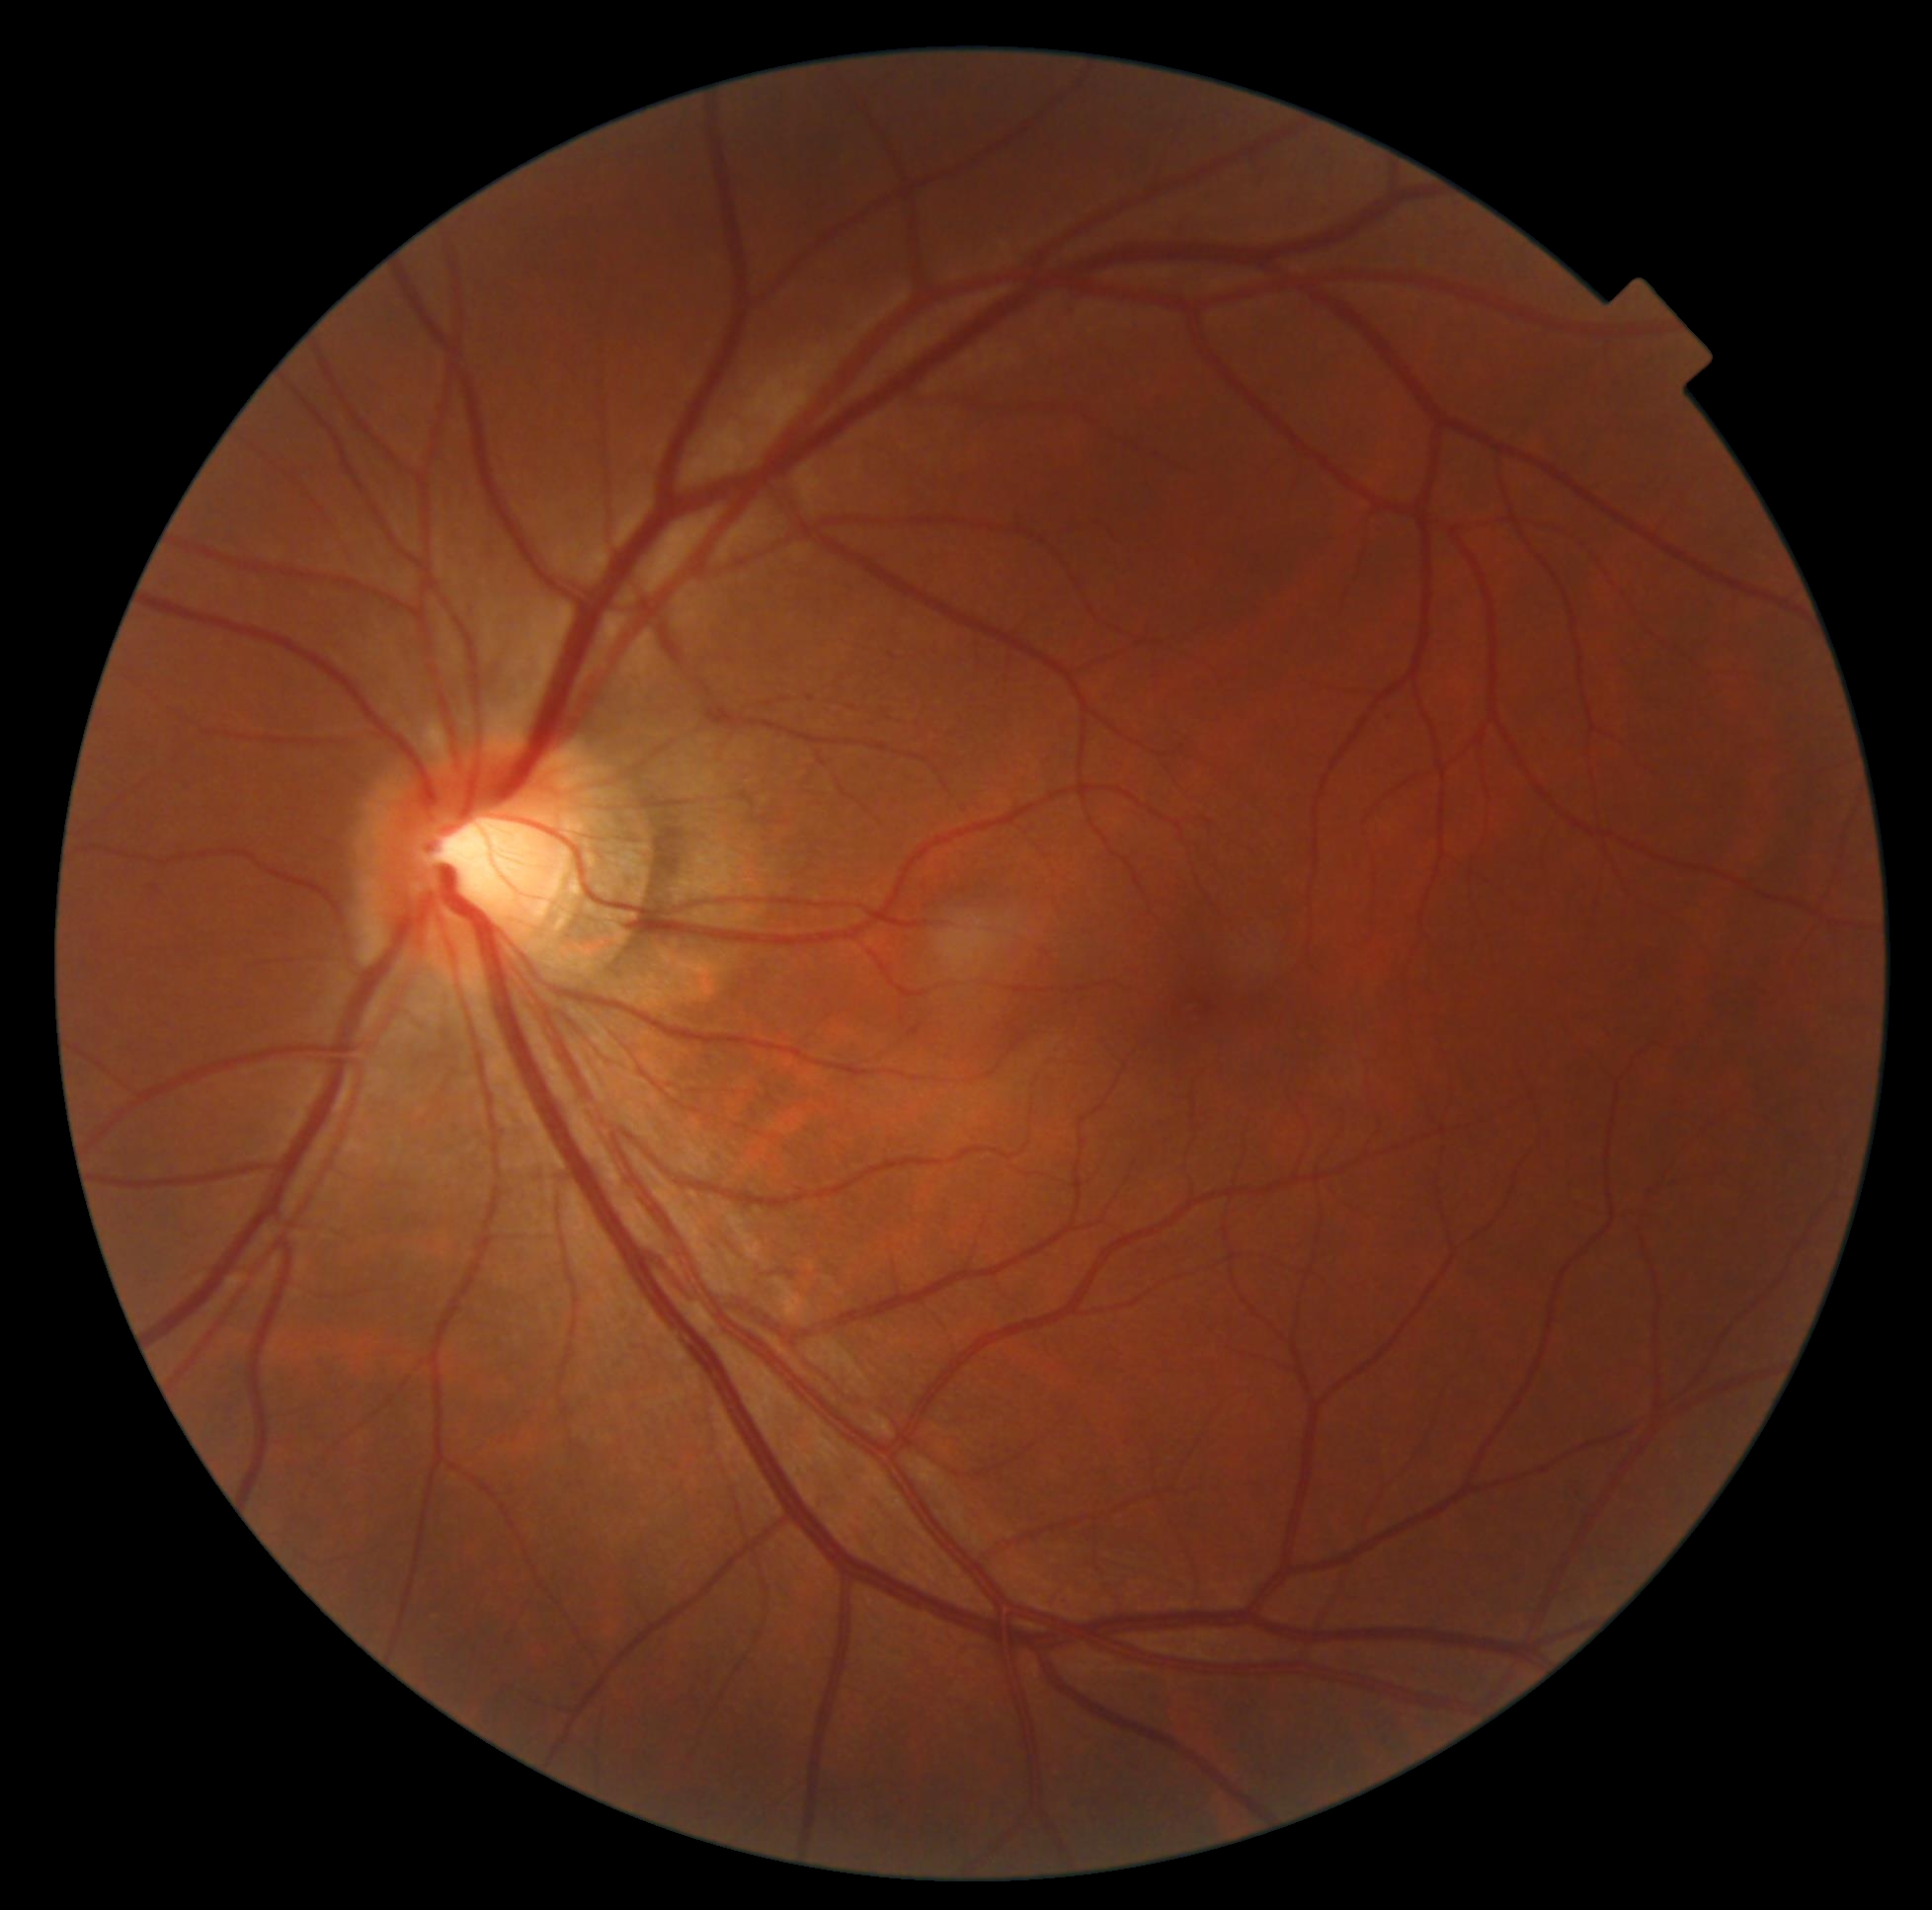

No apparent diabetic retinopathy. Retinopathy grade is 0.